NIDEK AFC-230 fundus camera · 45-degree field of view · diabetic retinopathy graded by the modified Davis classification · 848x848 · posterior pole color fundus photograph · no pharmacologic dilation: 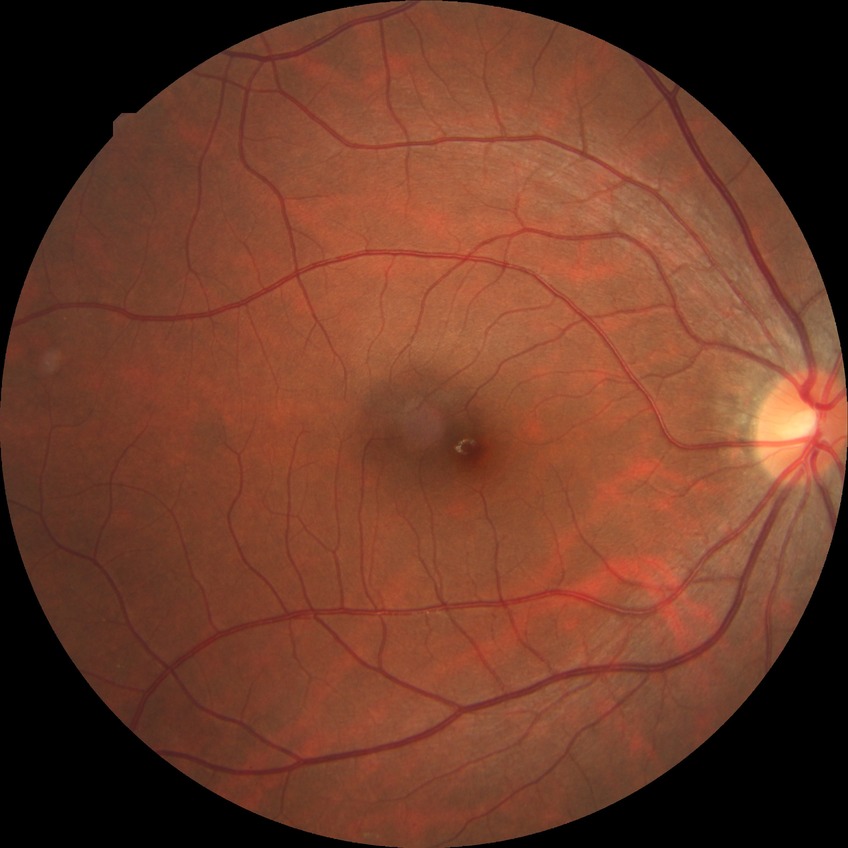

diabetic retinopathy (DR) = NDR (no diabetic retinopathy).